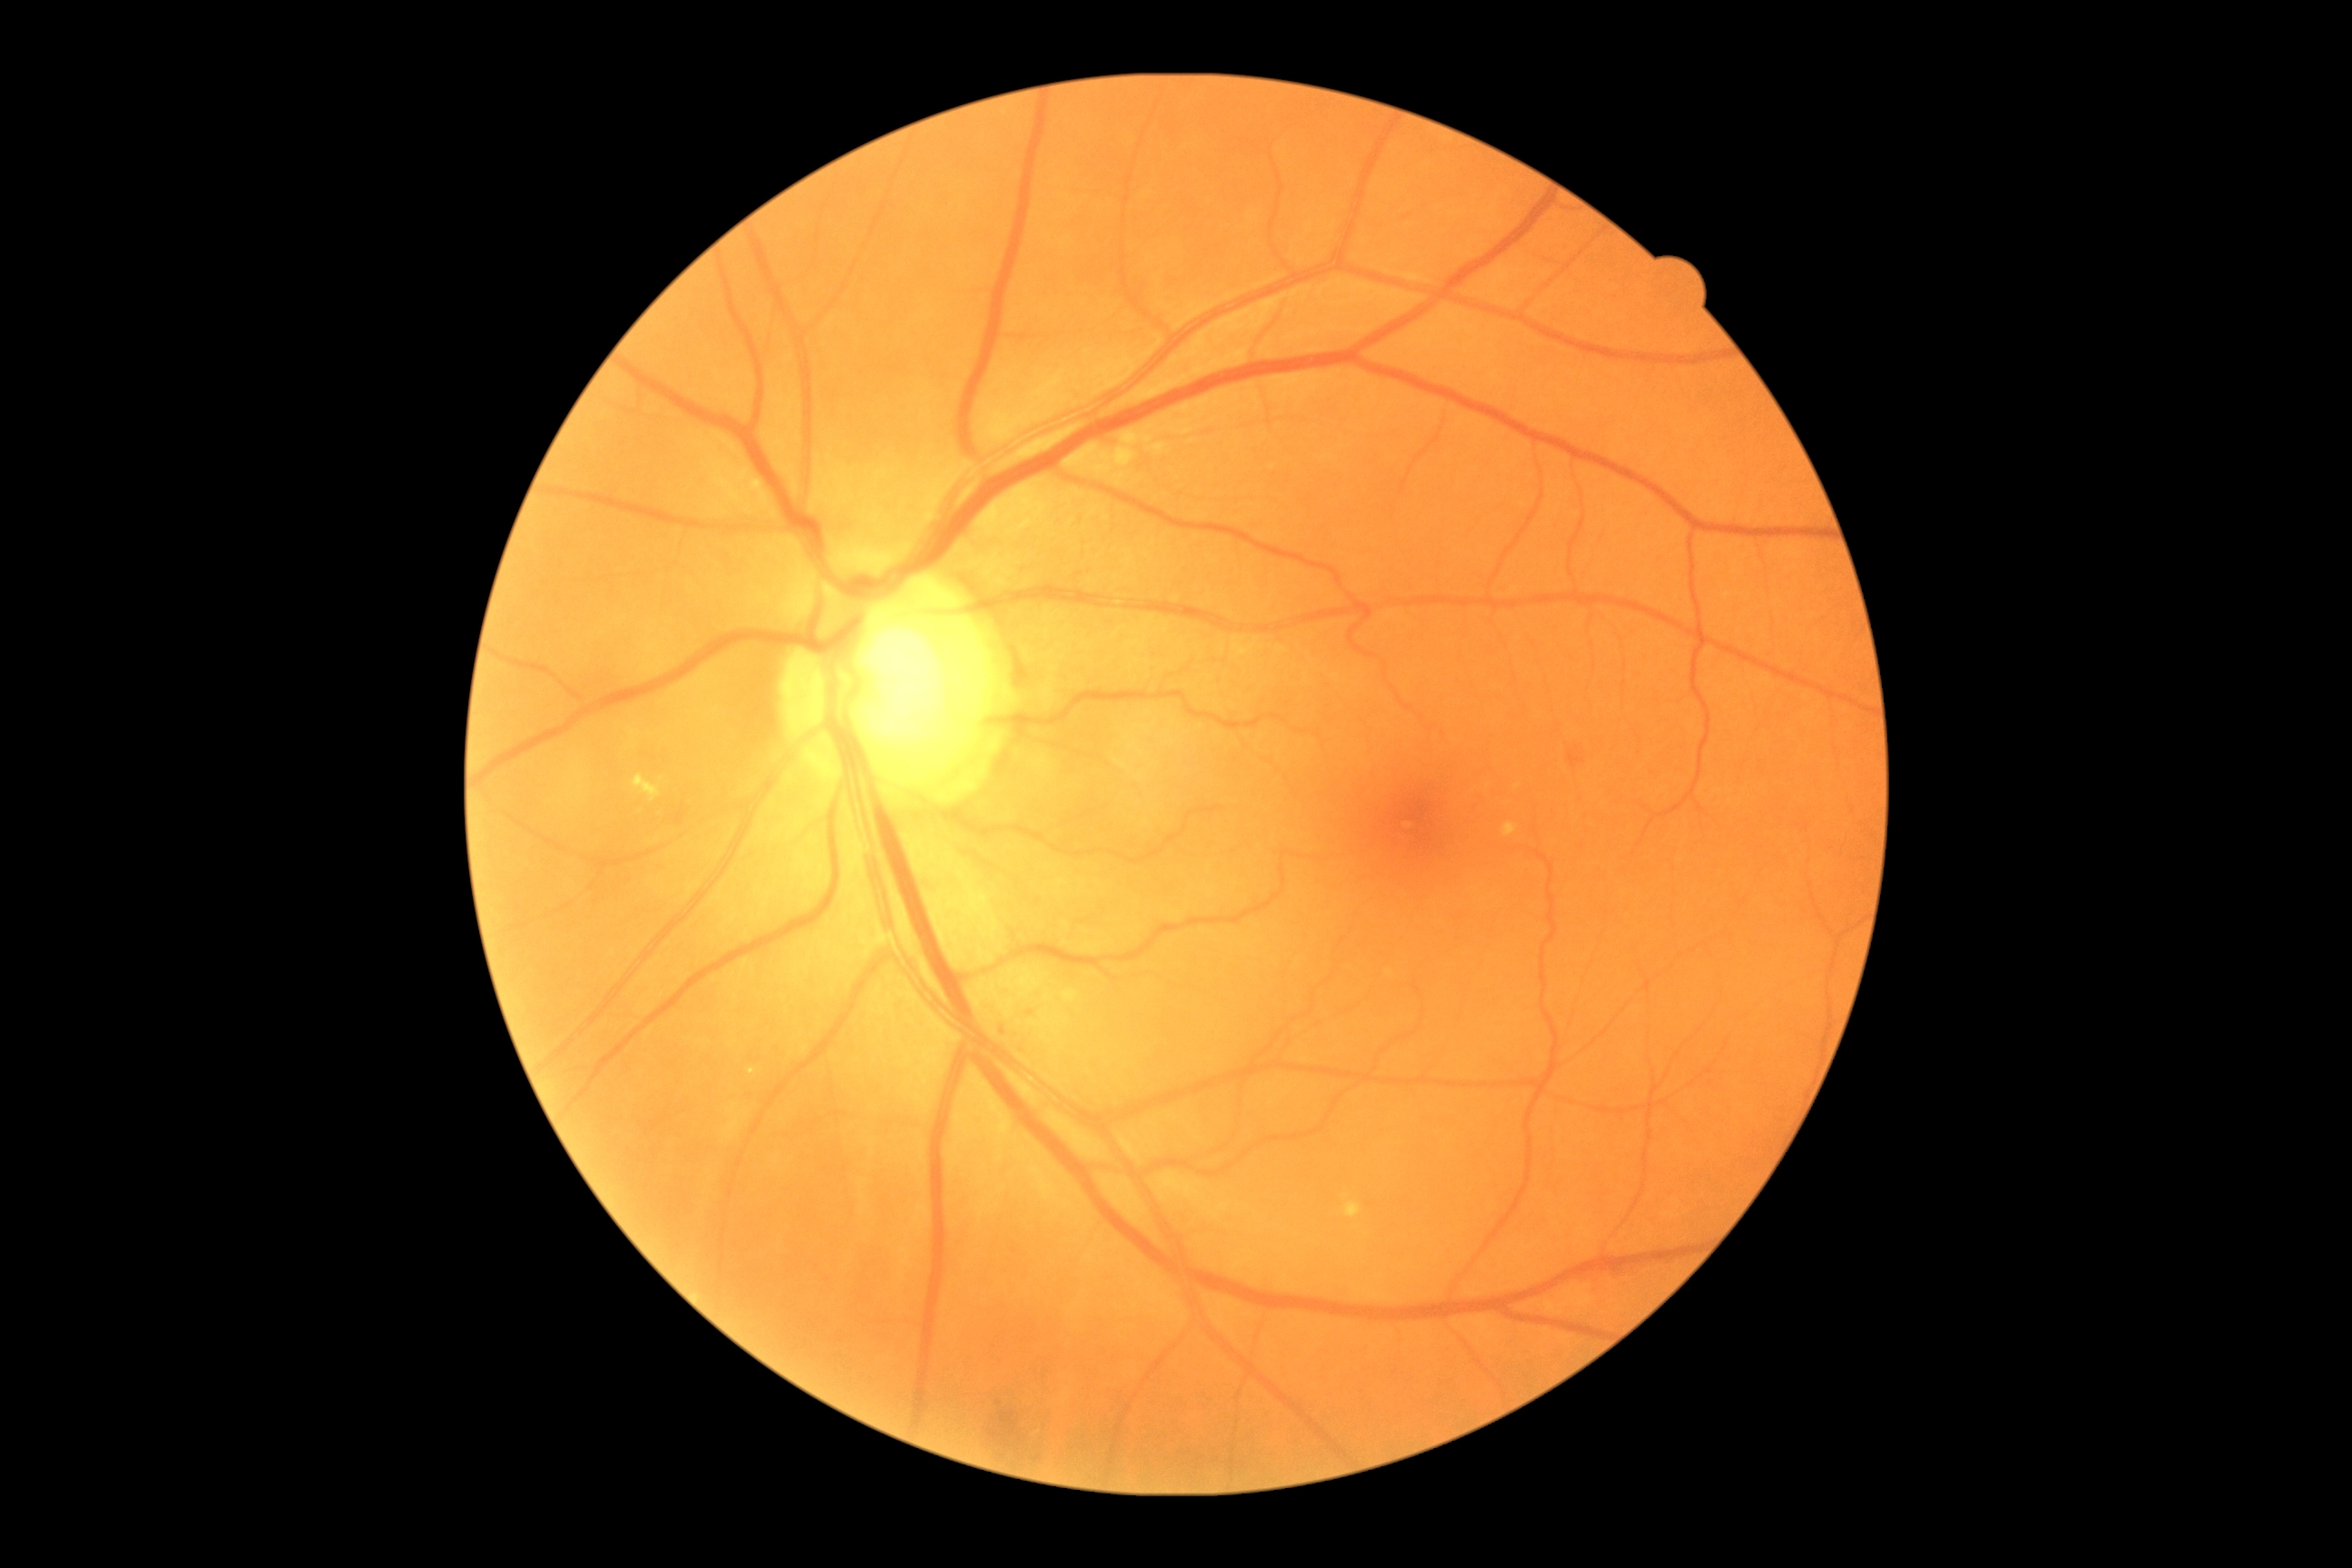
Diabetic retinopathy severity: 2.